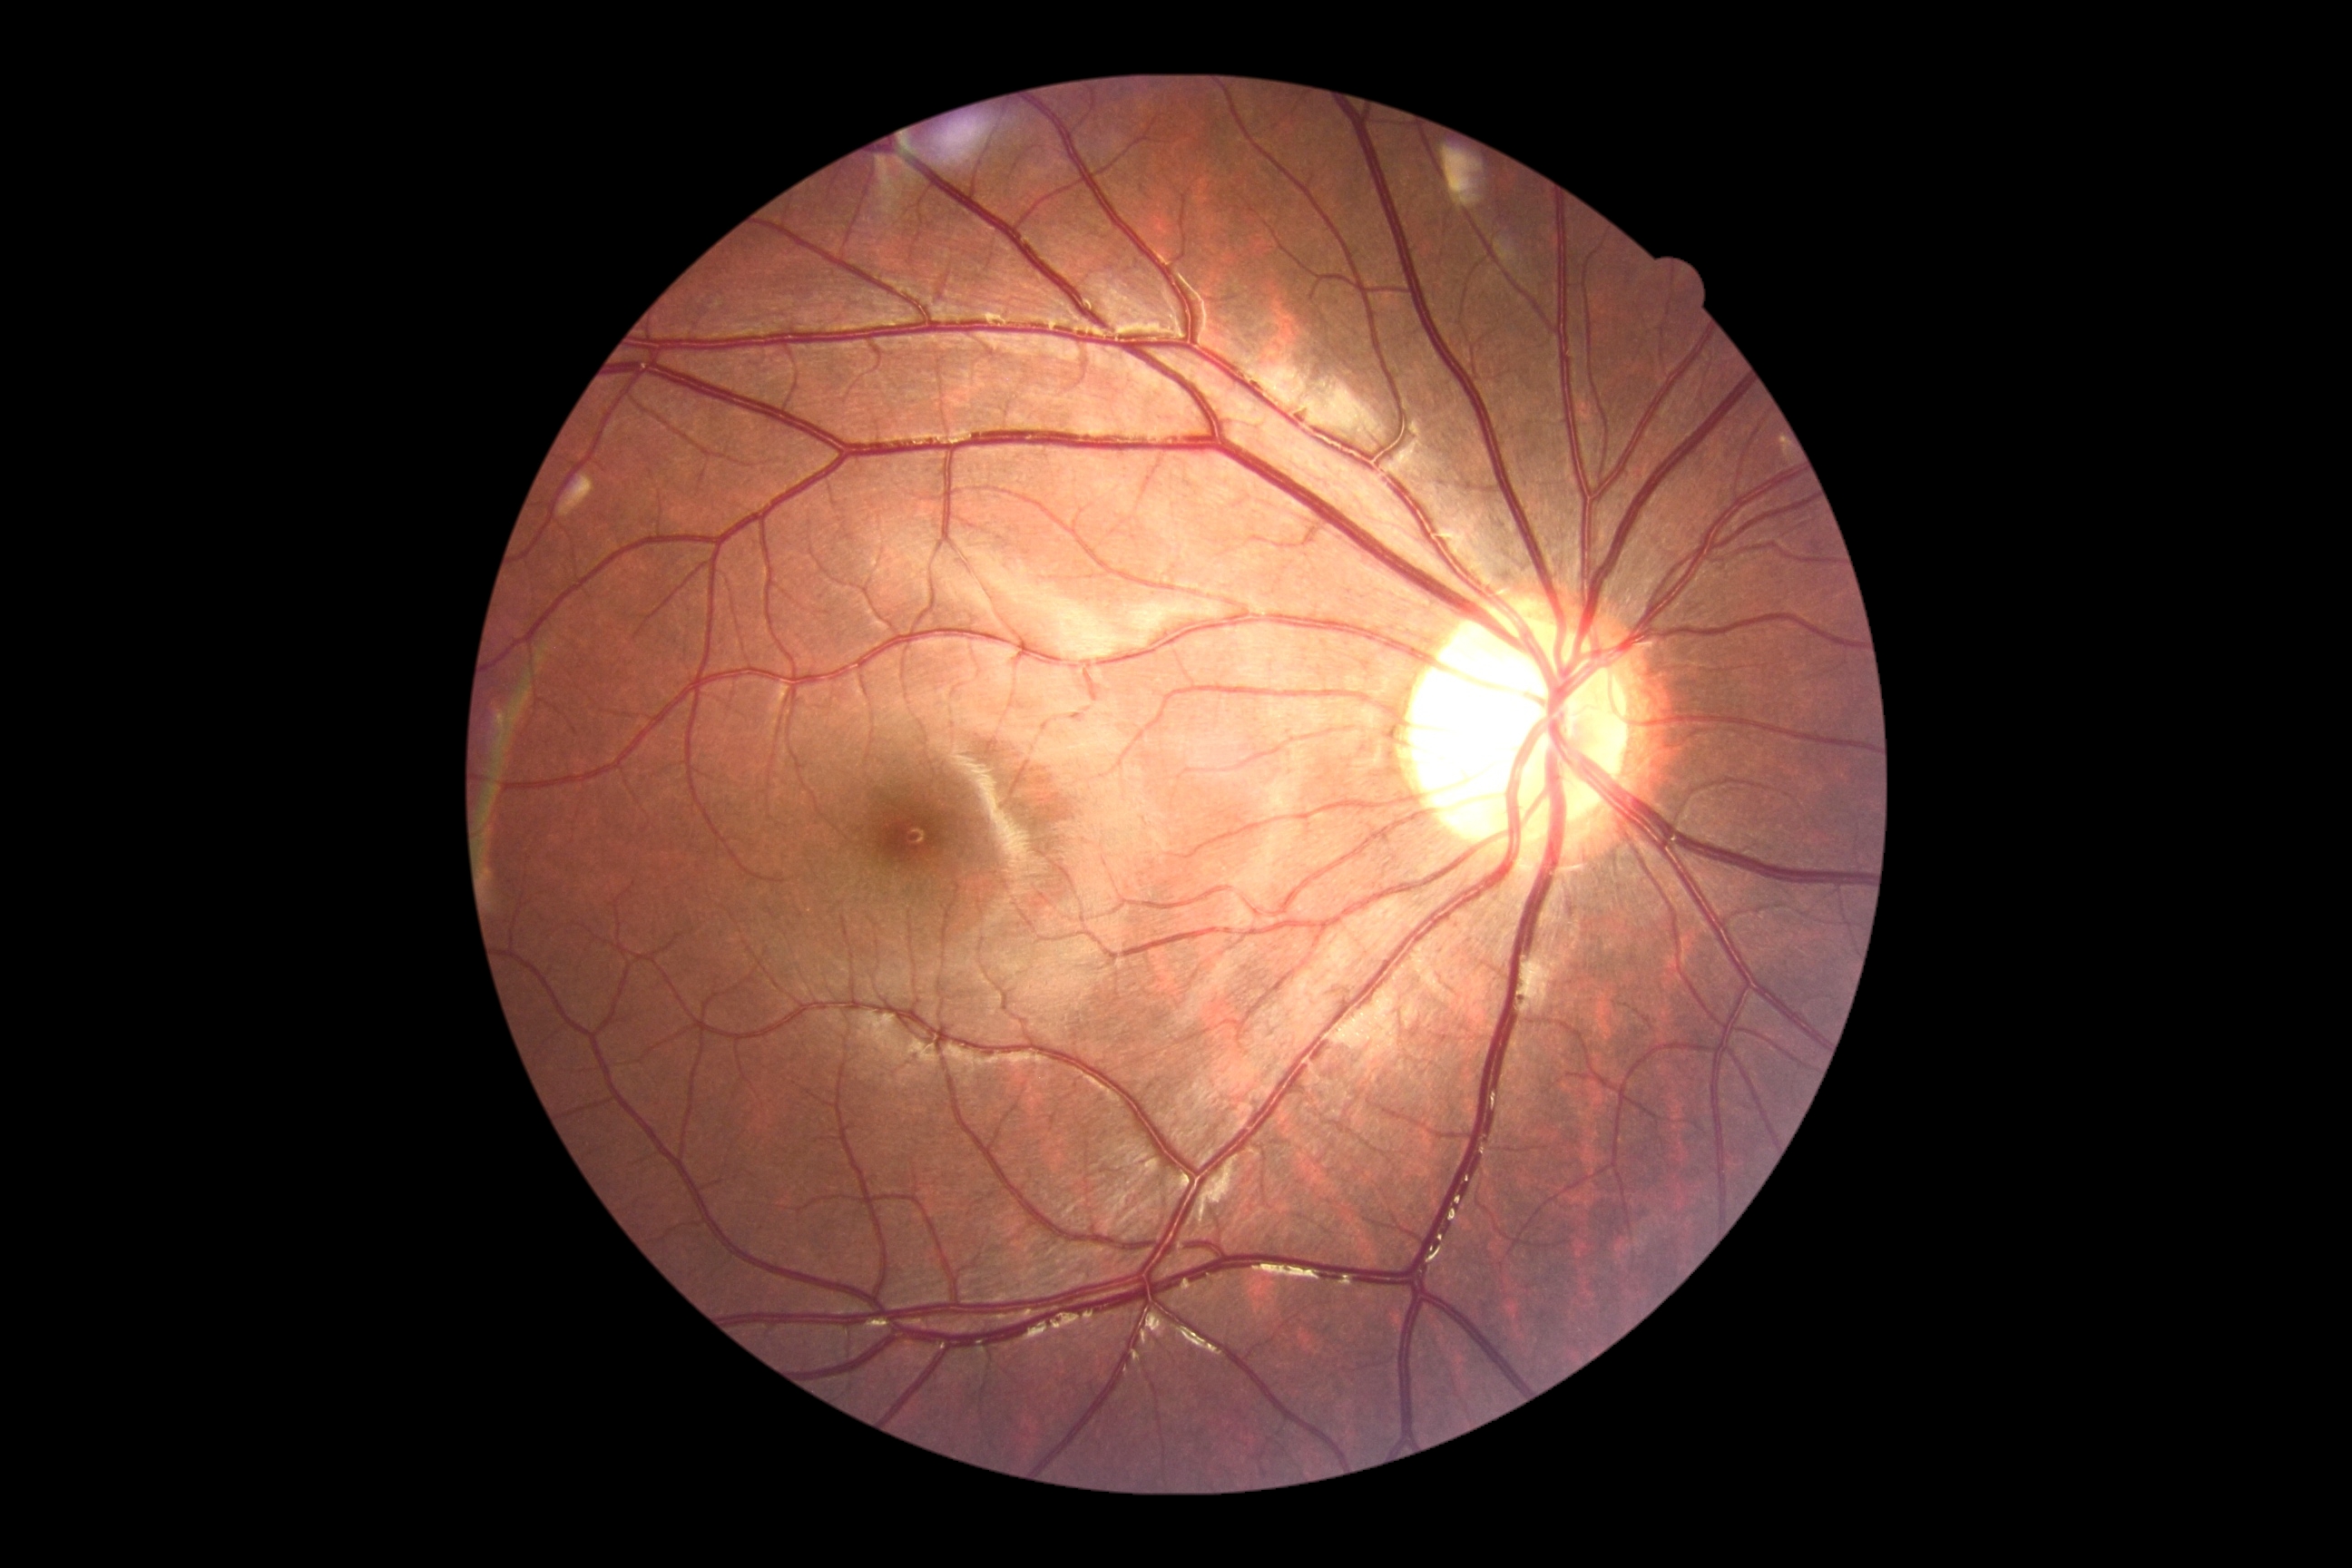
Annotations:
- DR impression: no signs of DR
- DR: 0/4